CFP
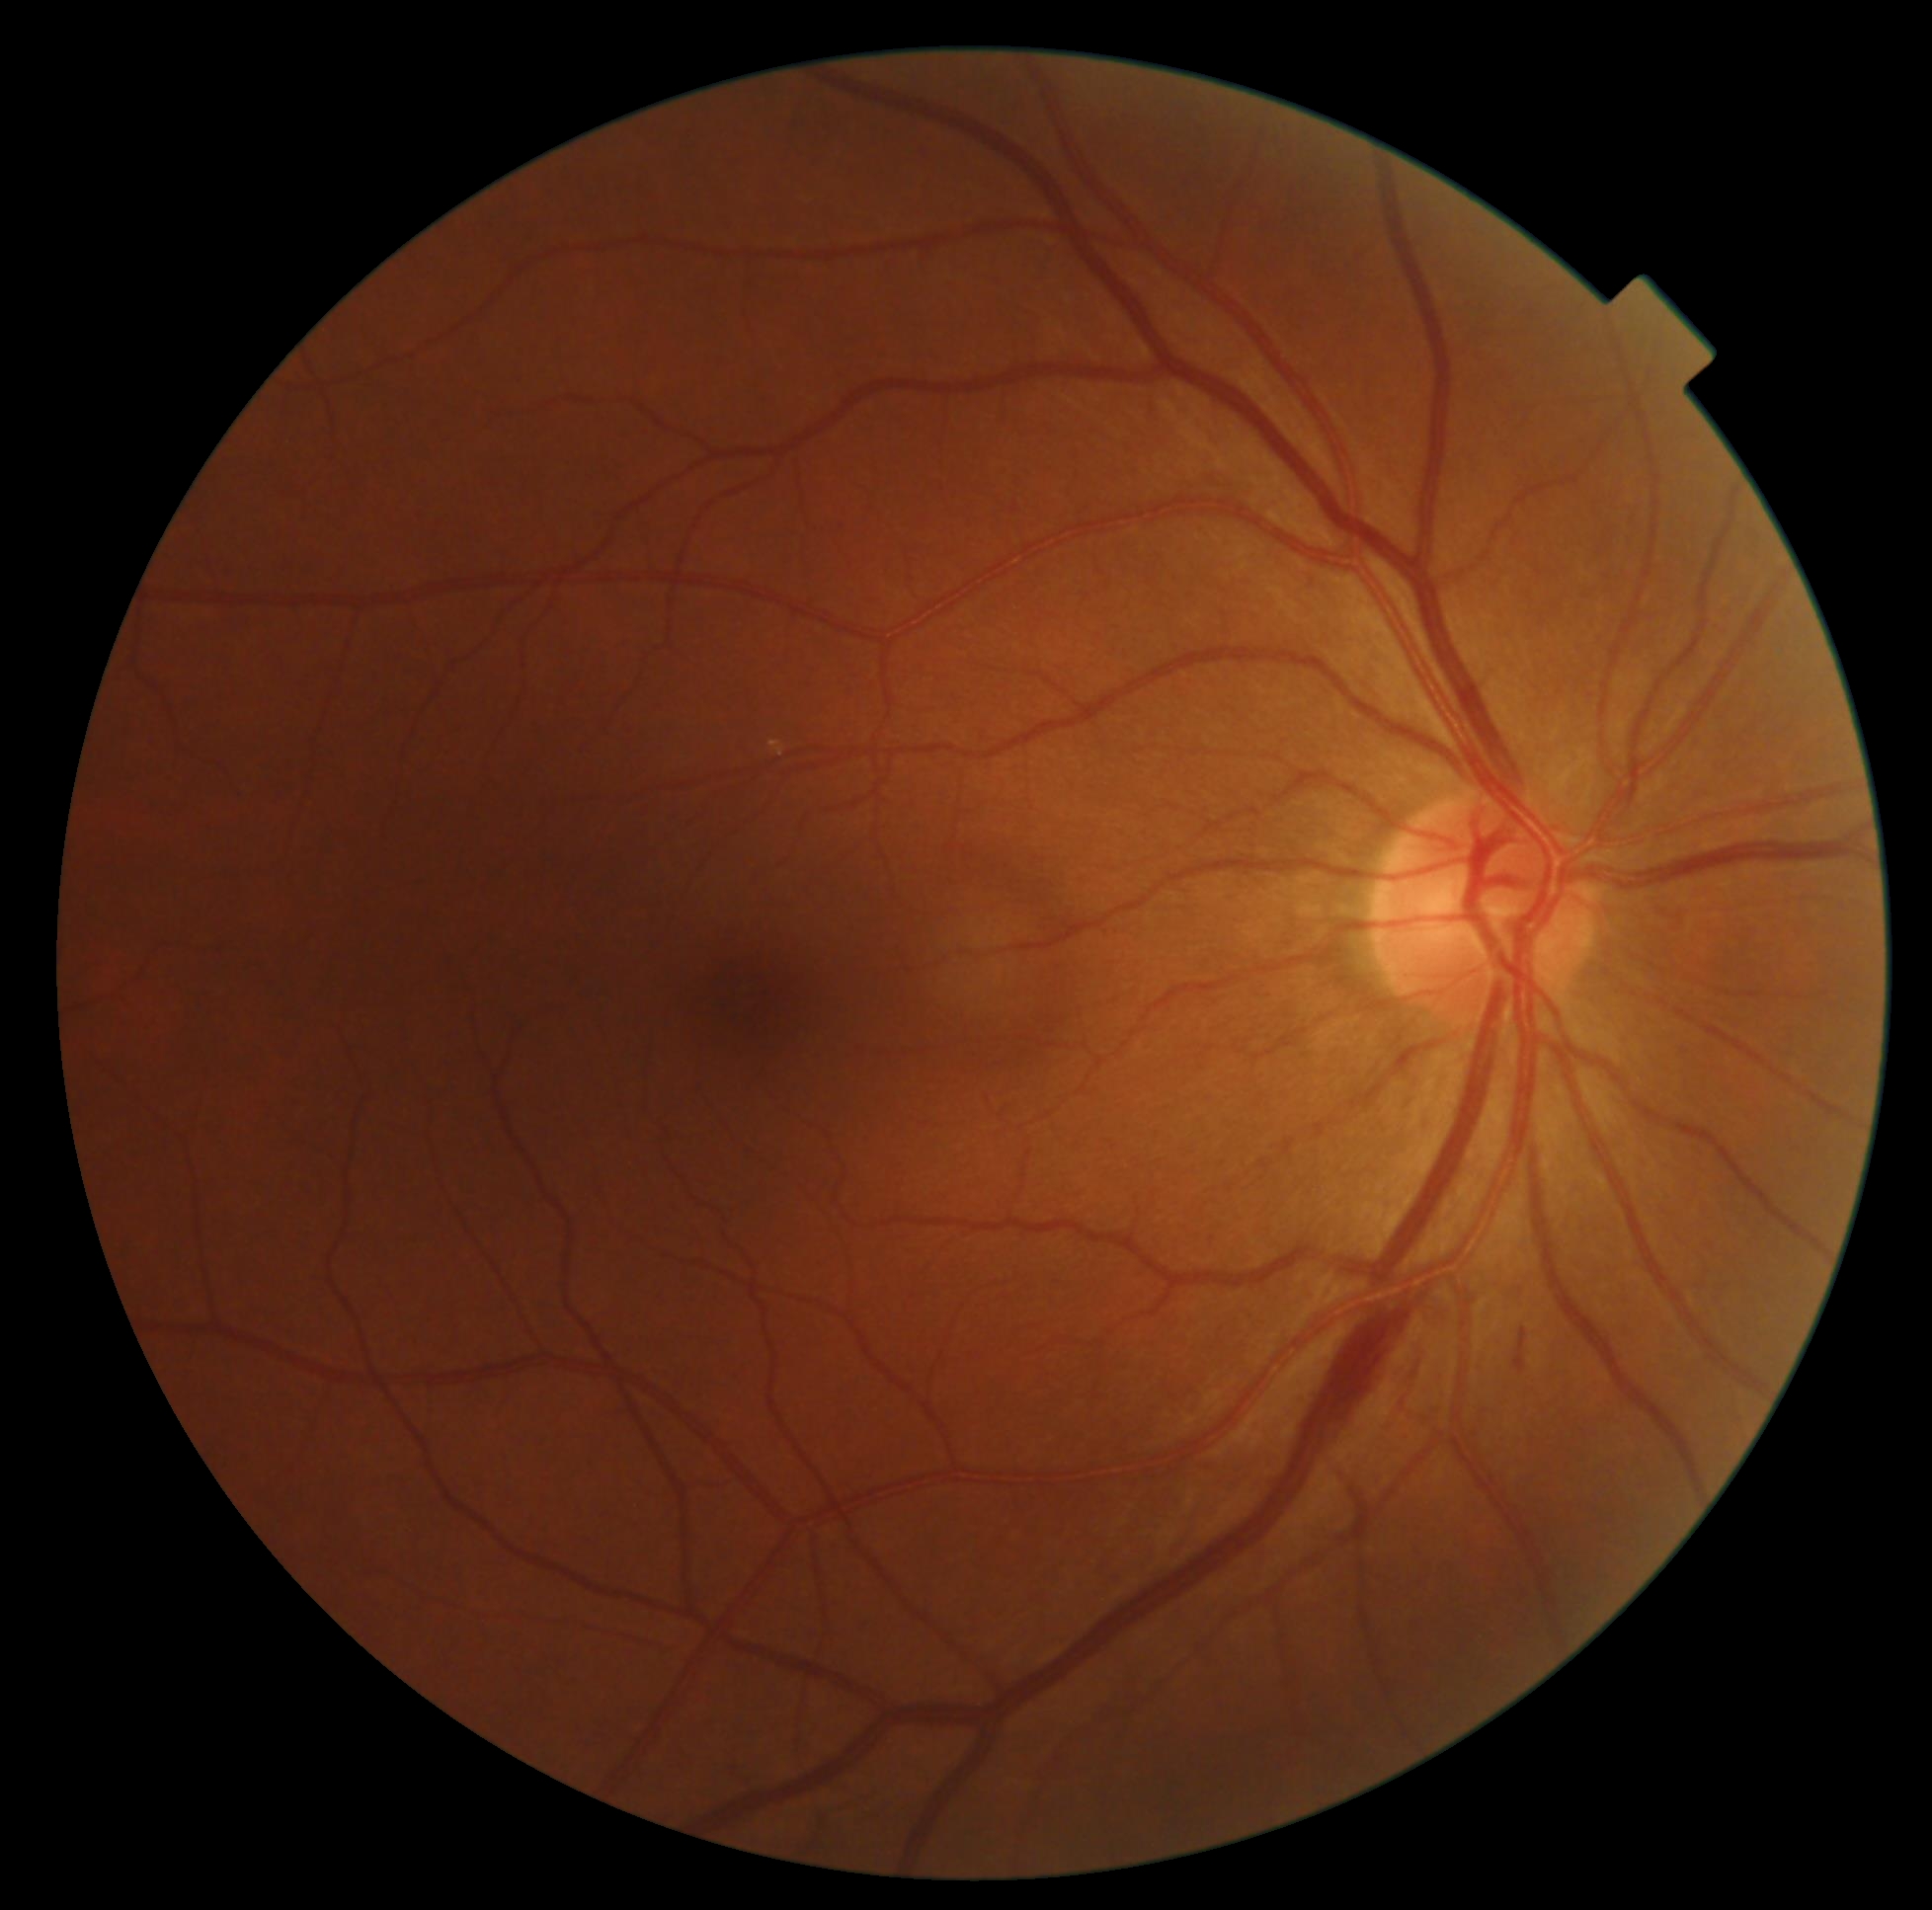
DR stage is 2/4.
The retinopathy is classified as non-proliferative diabetic retinopathy.